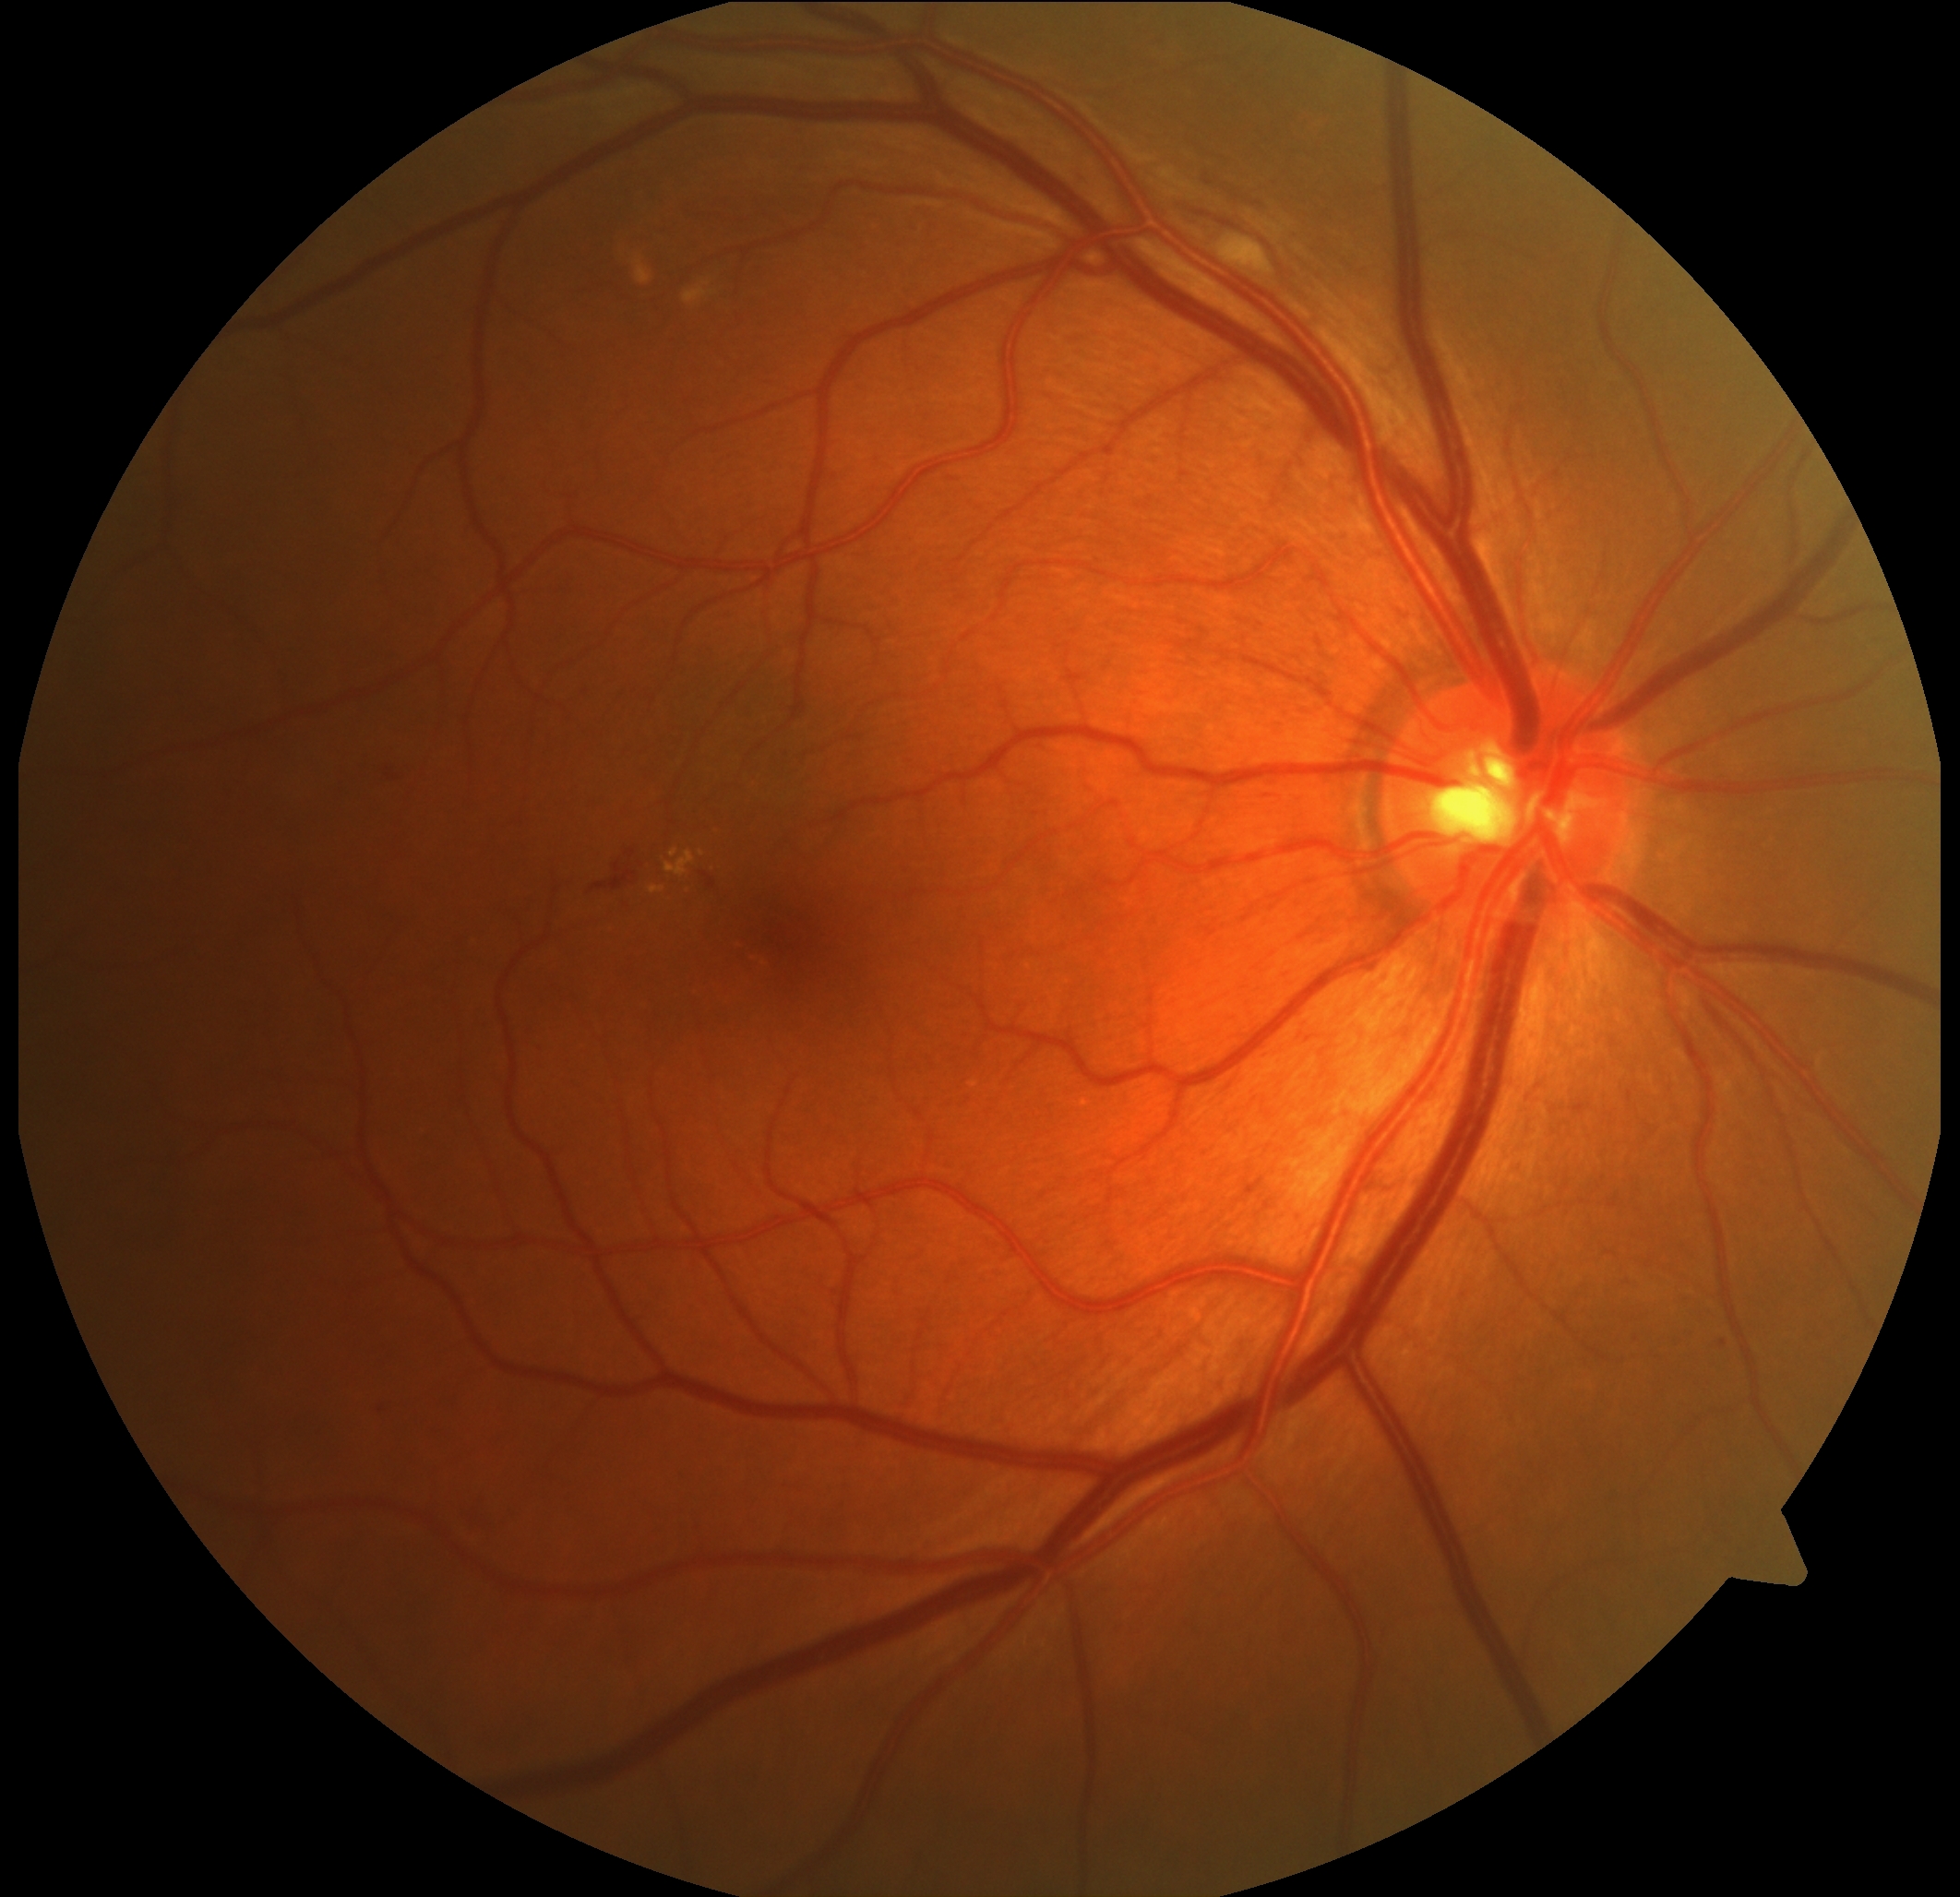
{"dr_grade": "grade 2 (moderate NPDR)"}